Ultra-widefield fundus photograph — 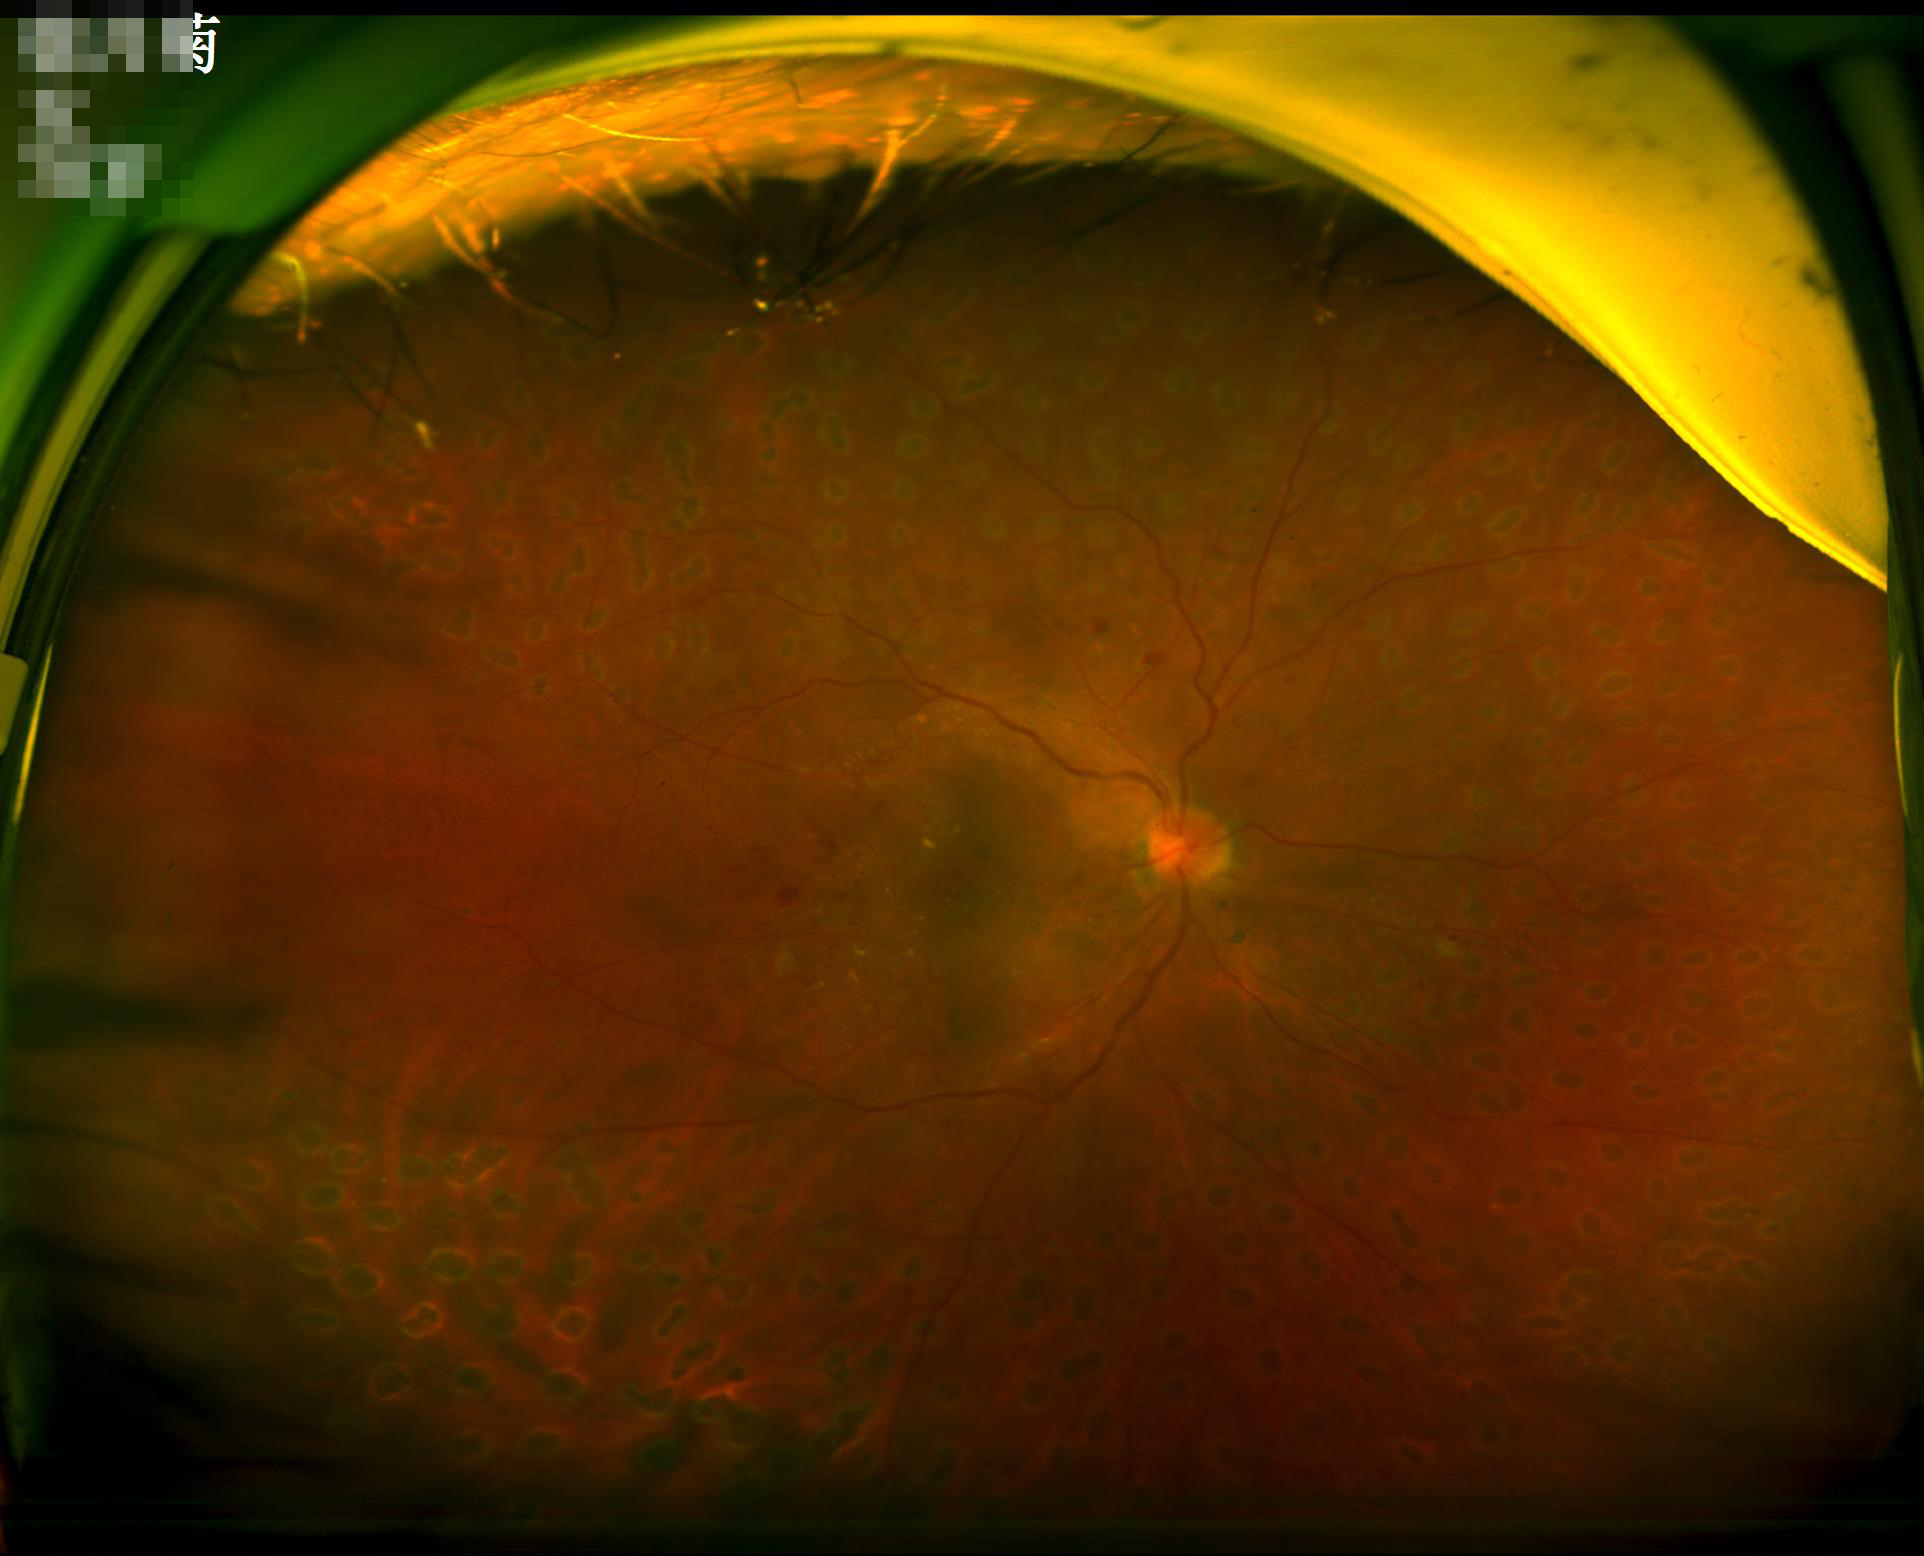

Contrast = good dynamic range
Illumination/color = no over- or under-exposure
Focus = sharp throughout the field
Overall quality = good, gradable